Color fundus photograph: 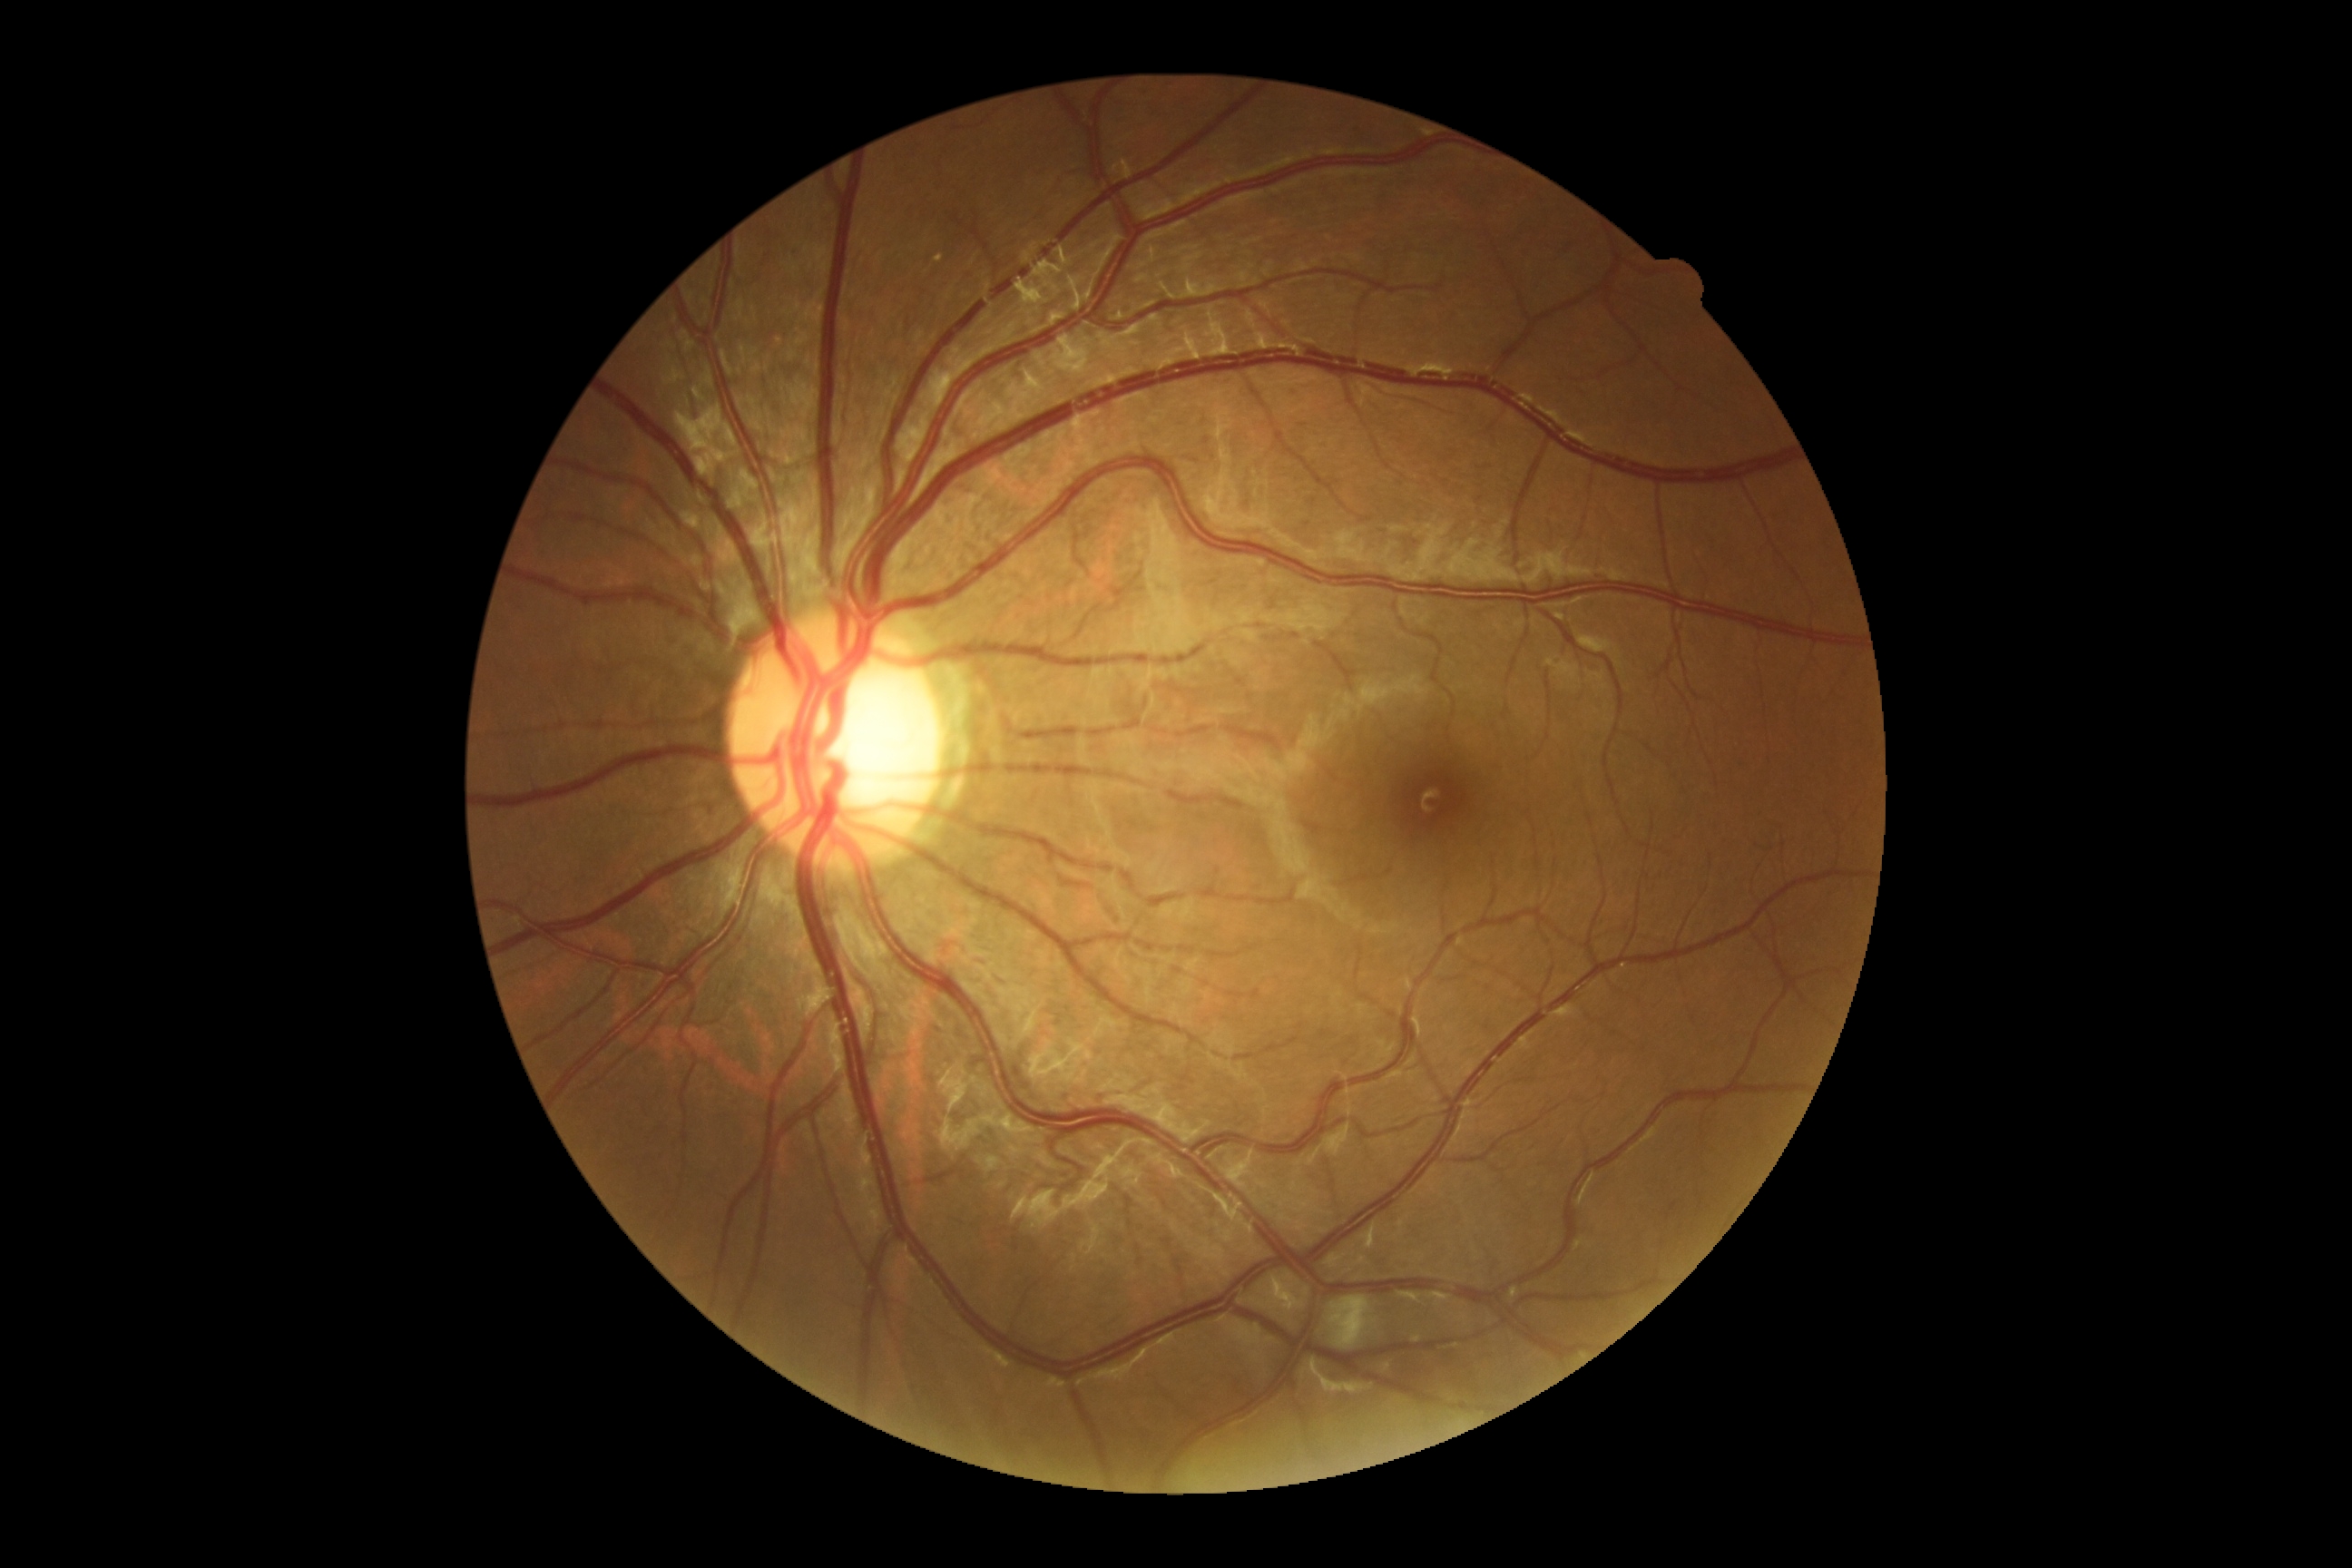
dr_impression: negative for DR
dr_grade: grade 0 (no apparent retinopathy)